Modified Davis grading
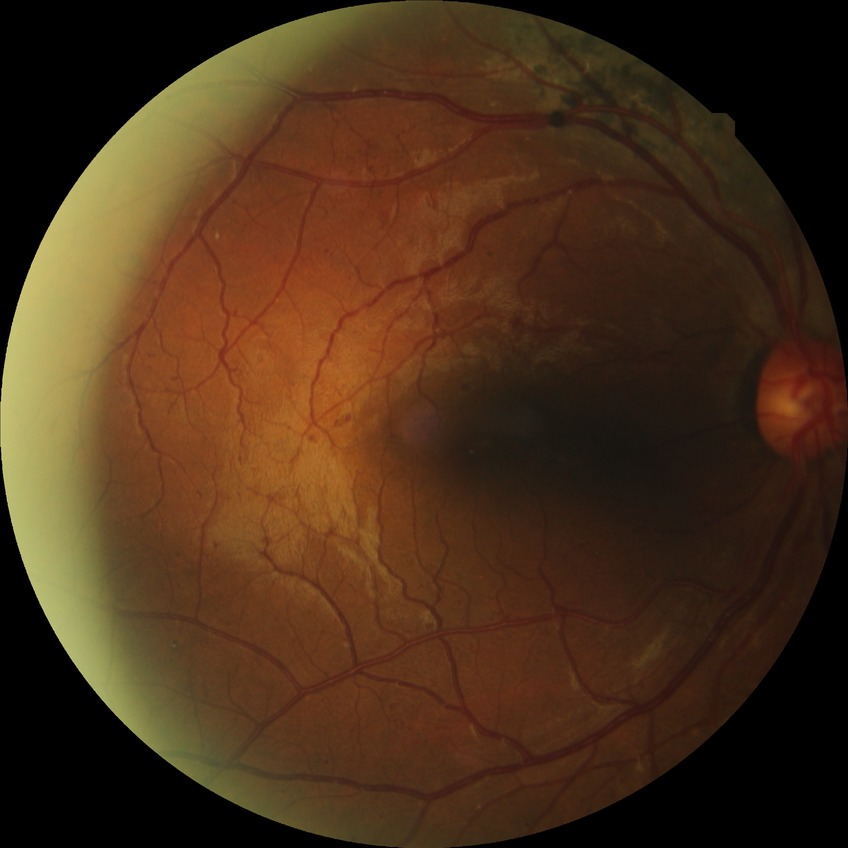

Findings:
- diabetic retinopathy (DR): PPDR (pre-proliferative diabetic retinopathy)